346x346px · optic nerve head photograph.
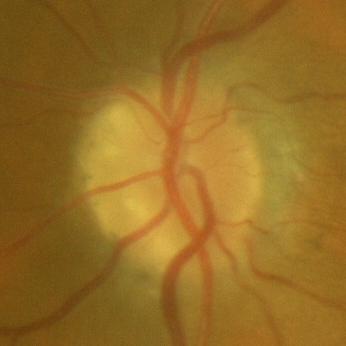
Showing no glaucomatous damage.